Phoenix ICON, 100° FOV; pediatric retinal photograph (wide-field) — 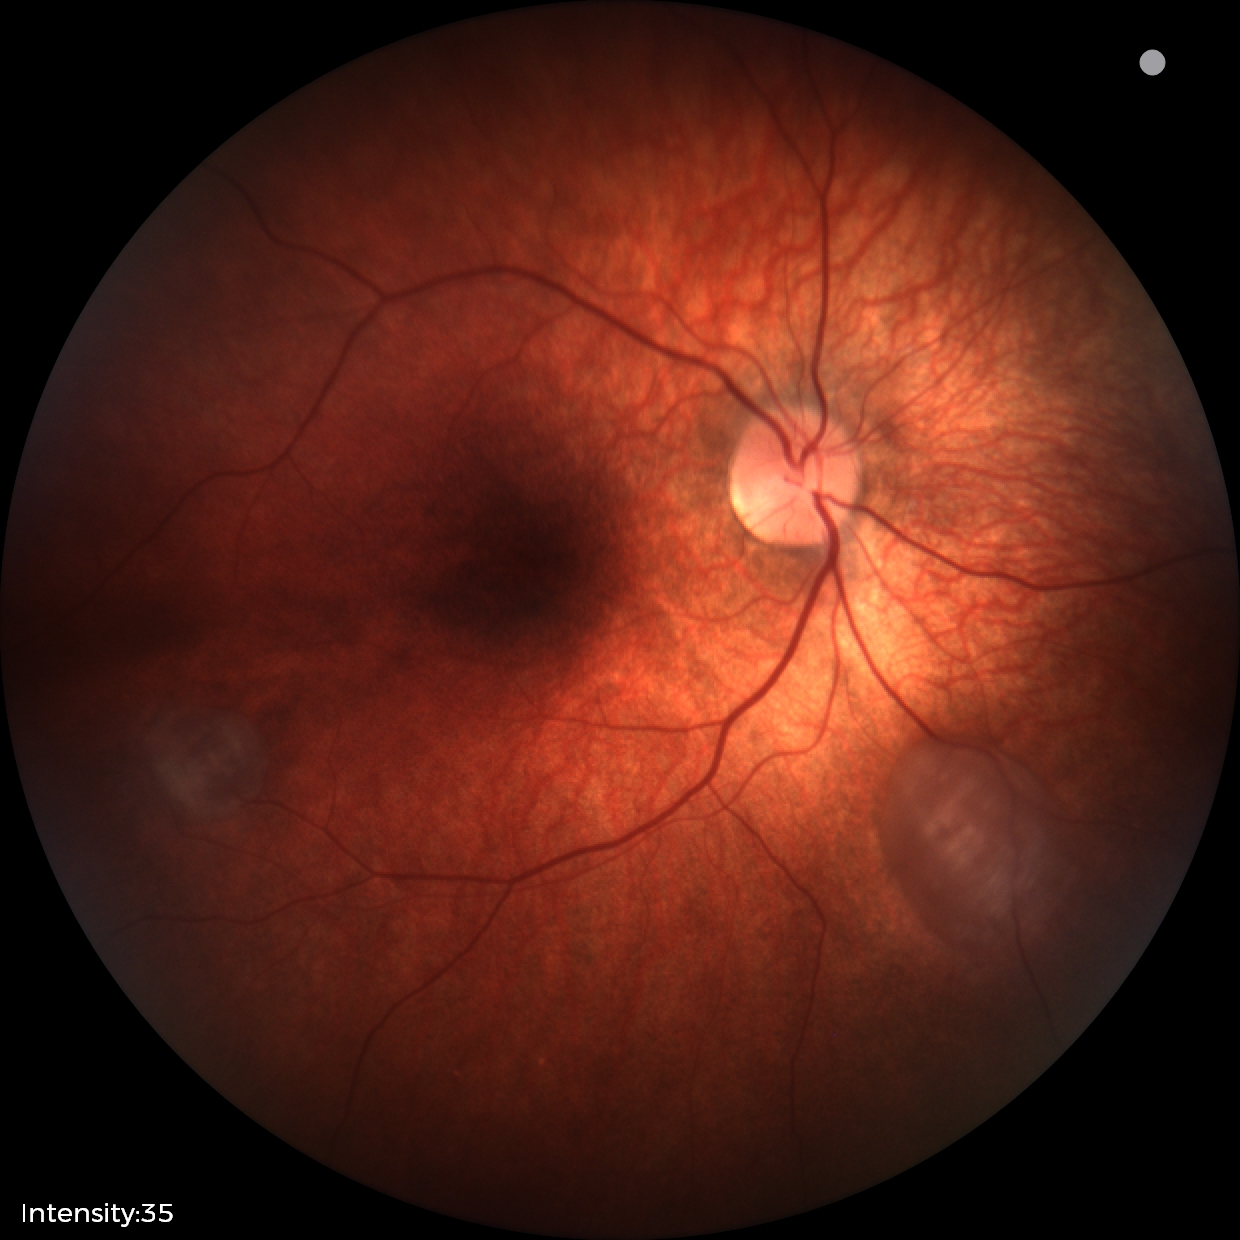
Screening series with retinal astrocytic hamartoma.